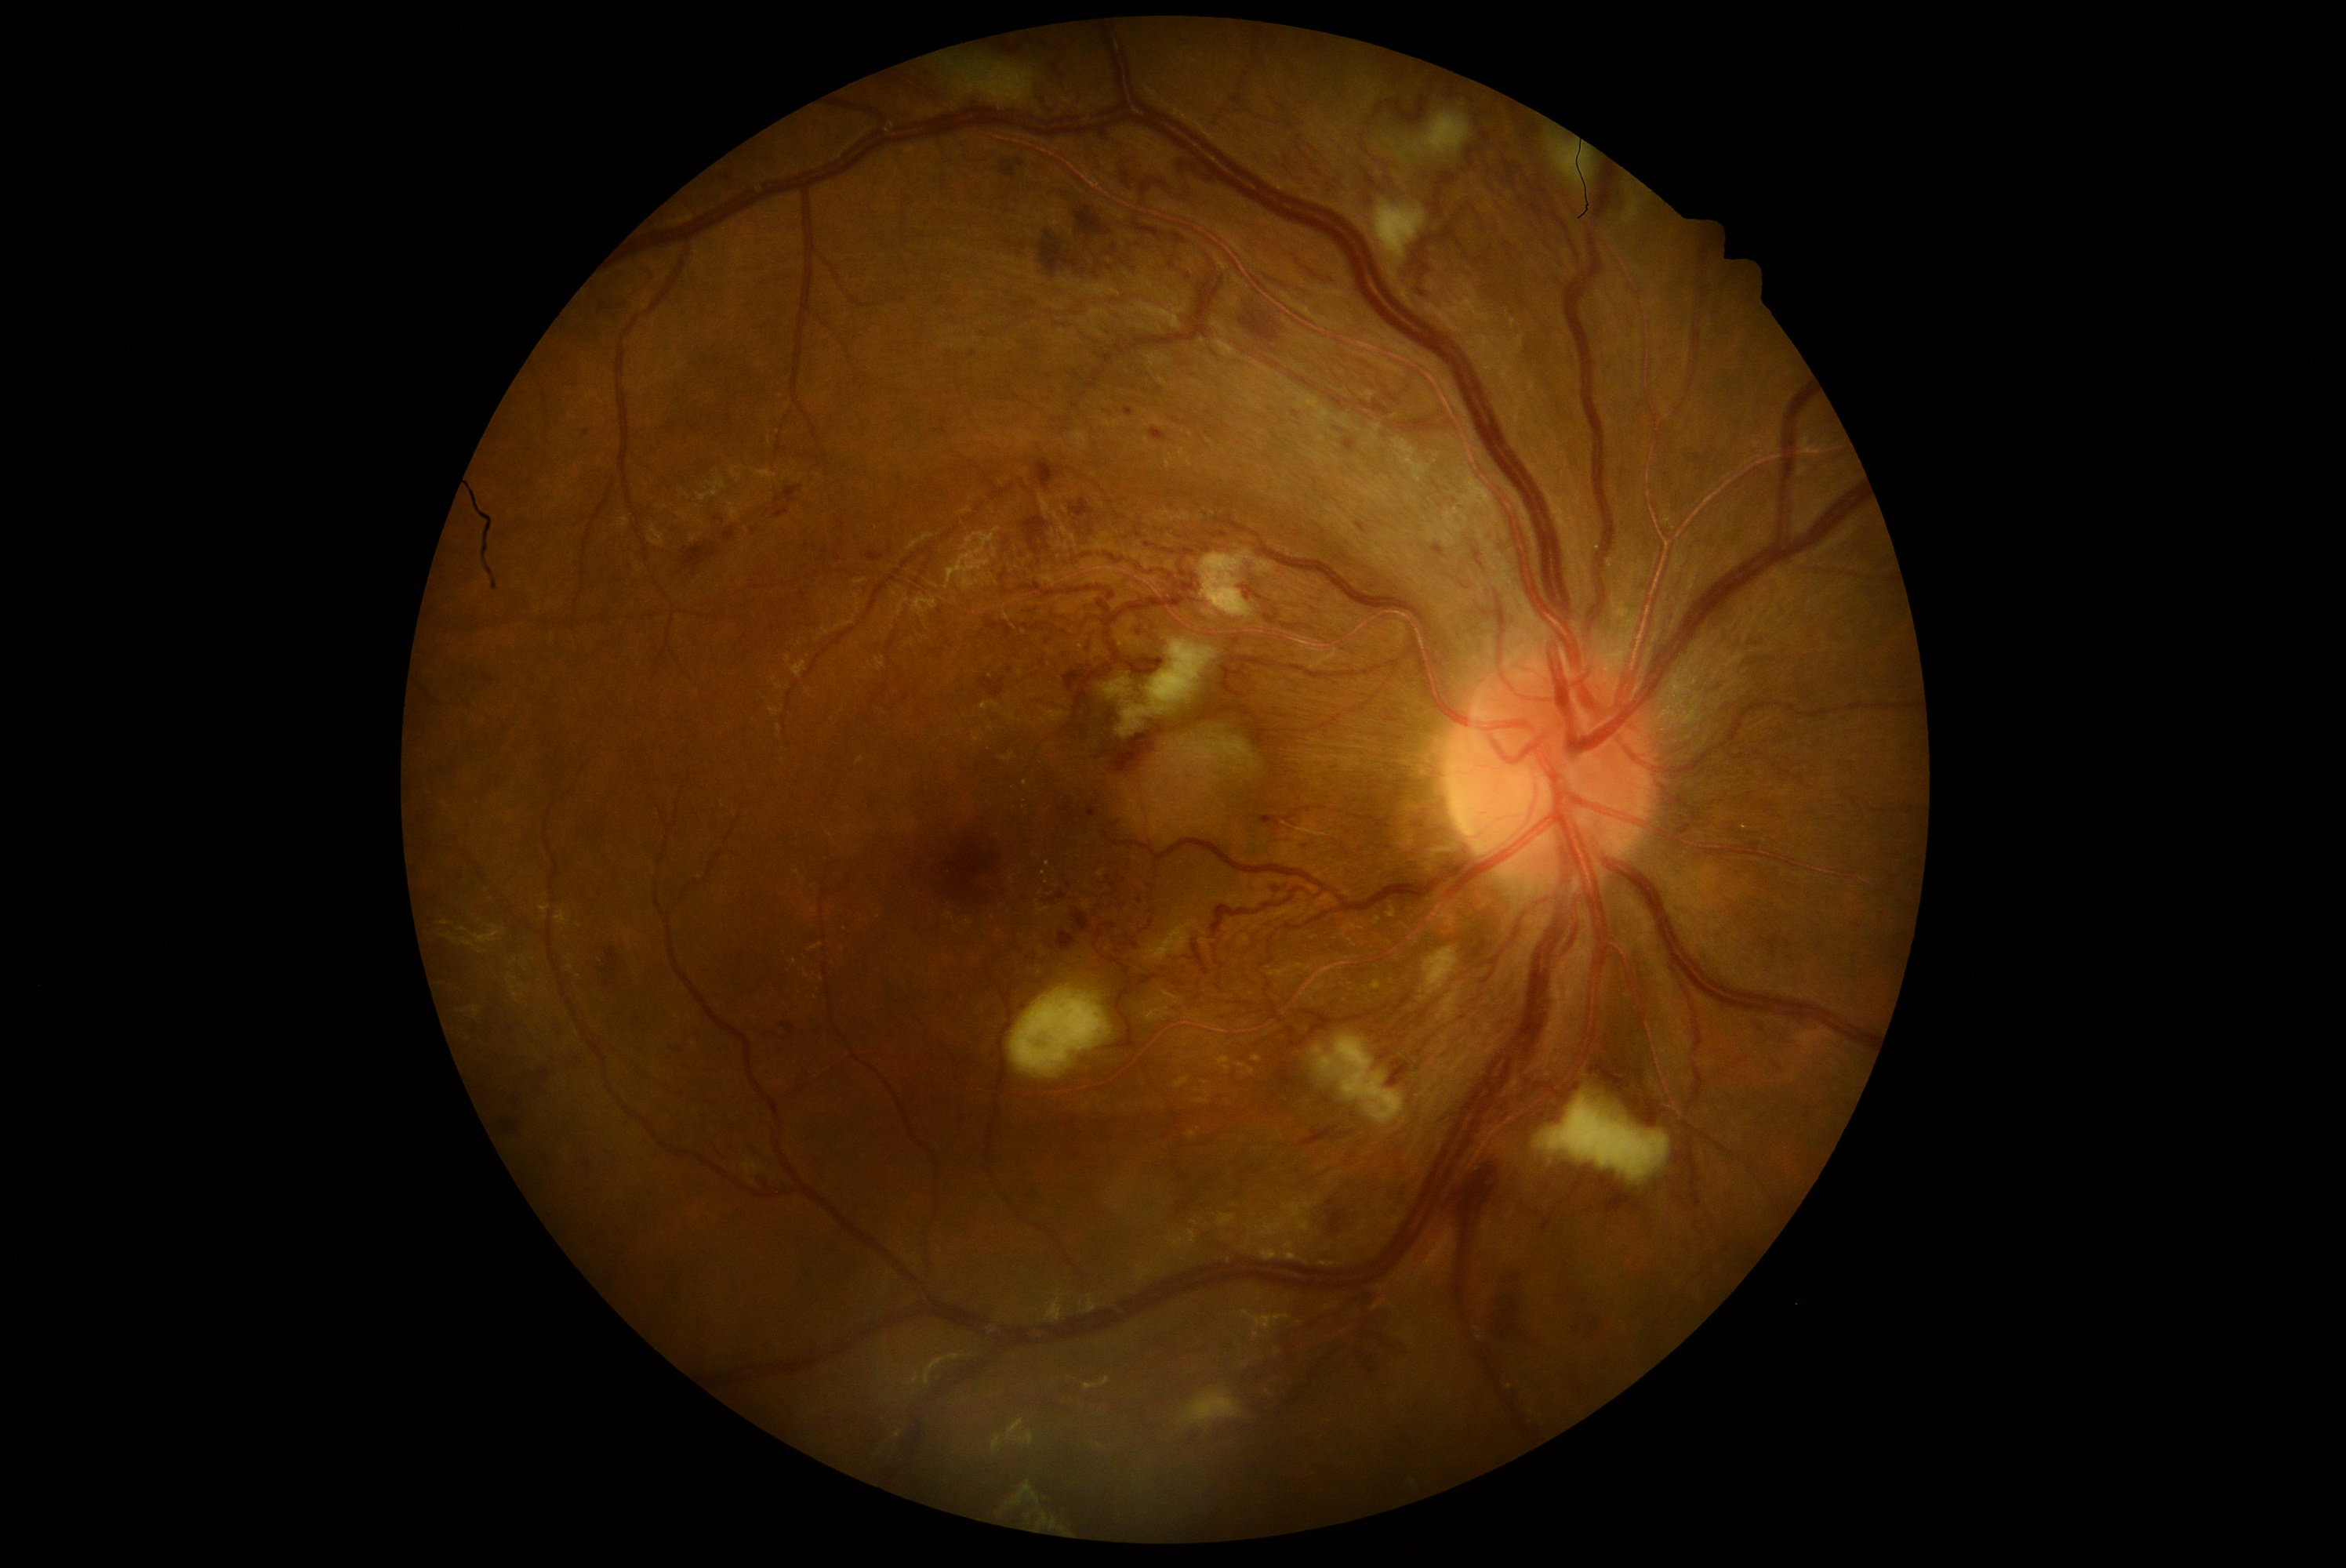 <lesions partial="true">
  <dr_grade>3</dr_grade>
  <he partial="true">[x1=1694, y1=456, x2=1709, y2=463]; [x1=1136, y1=628, x2=1142, y2=636]; [x1=1088, y1=810, x2=1097, y2=818]; [x1=1762, y1=935, x2=1781, y2=957]; [x1=1302, y1=1127, x2=1356, y2=1147]; [x1=1299, y1=1161, x2=1332, y2=1181]; [x1=1023, y1=517, x2=1048, y2=556]; [x1=1357, y1=1304, x2=1415, y2=1376]; [x1=868, y1=553, x2=884, y2=562]; [x1=678, y1=543, x2=721, y2=575]; [x1=1001, y1=161, x2=1015, y2=180]; [x1=1243, y1=297, x2=1262, y2=310]; [x1=1356, y1=523, x2=1365, y2=534]; [x1=1329, y1=1210, x2=1349, y2=1235]; [x1=1149, y1=426, x2=1168, y2=443]; [x1=1058, y1=932, x2=1077, y2=951]</he>
  <he_small>[1047,641]; [1010,670]</he_small>
</lesions>